Acquired on the Phoenix ICON; infant wide-field fundus photograph: 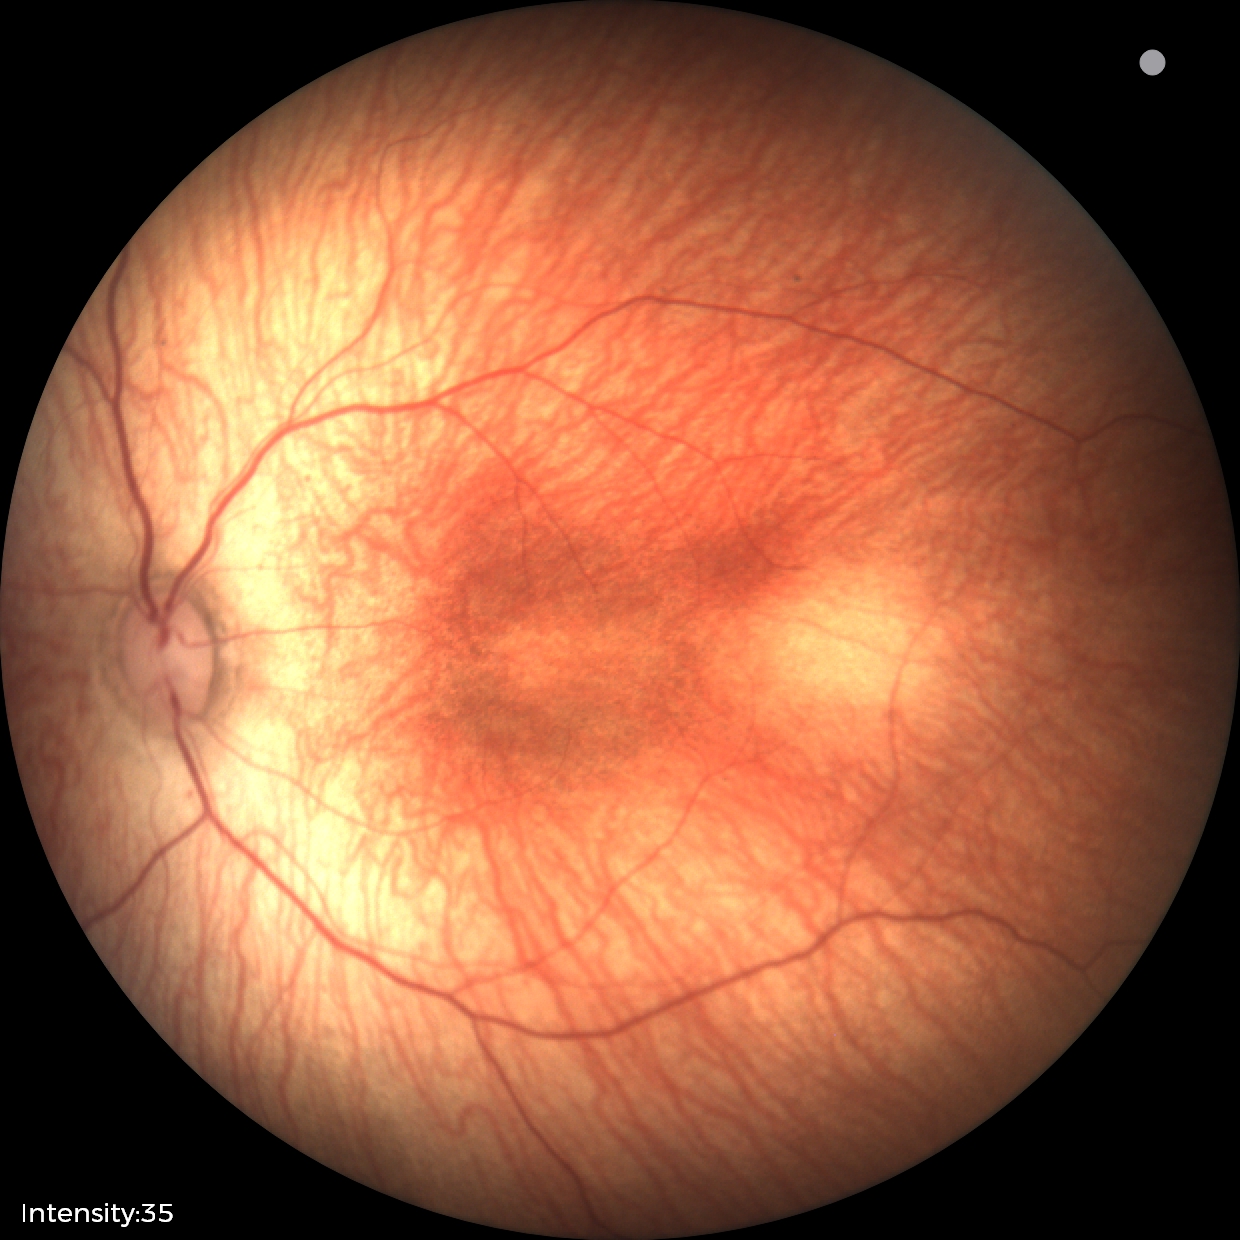

Without plus disease.
Screening series with status post retinopathy of prematurity.